45° field of view, NIDEK AFC-230
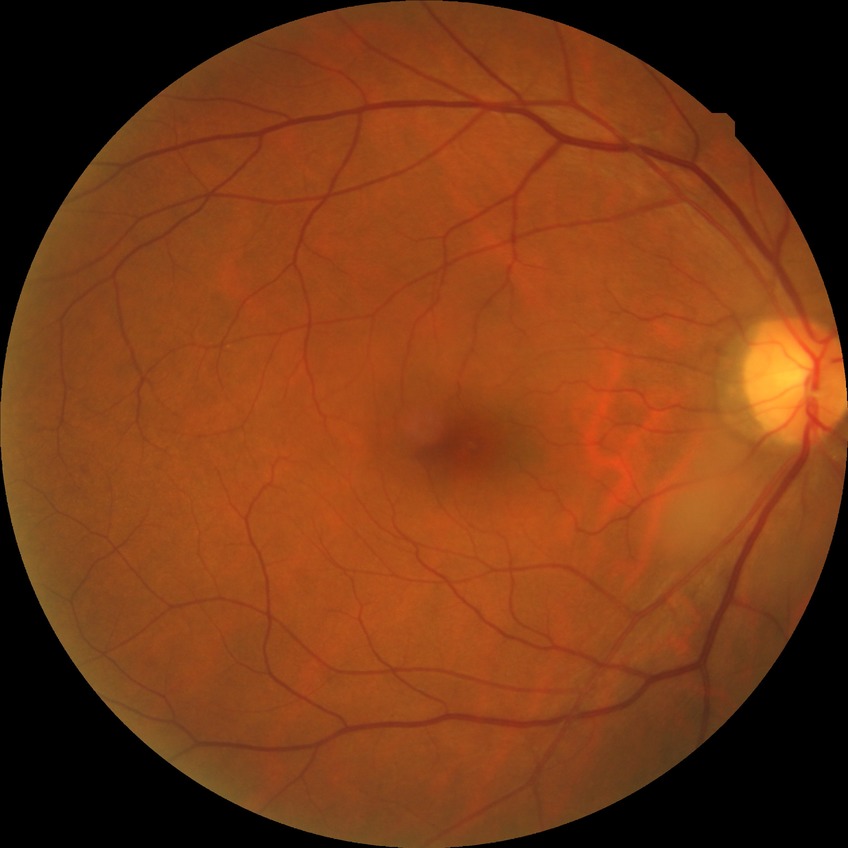

DR is NDR.
No signs of diabetic retinopathy.